2352x1568px — 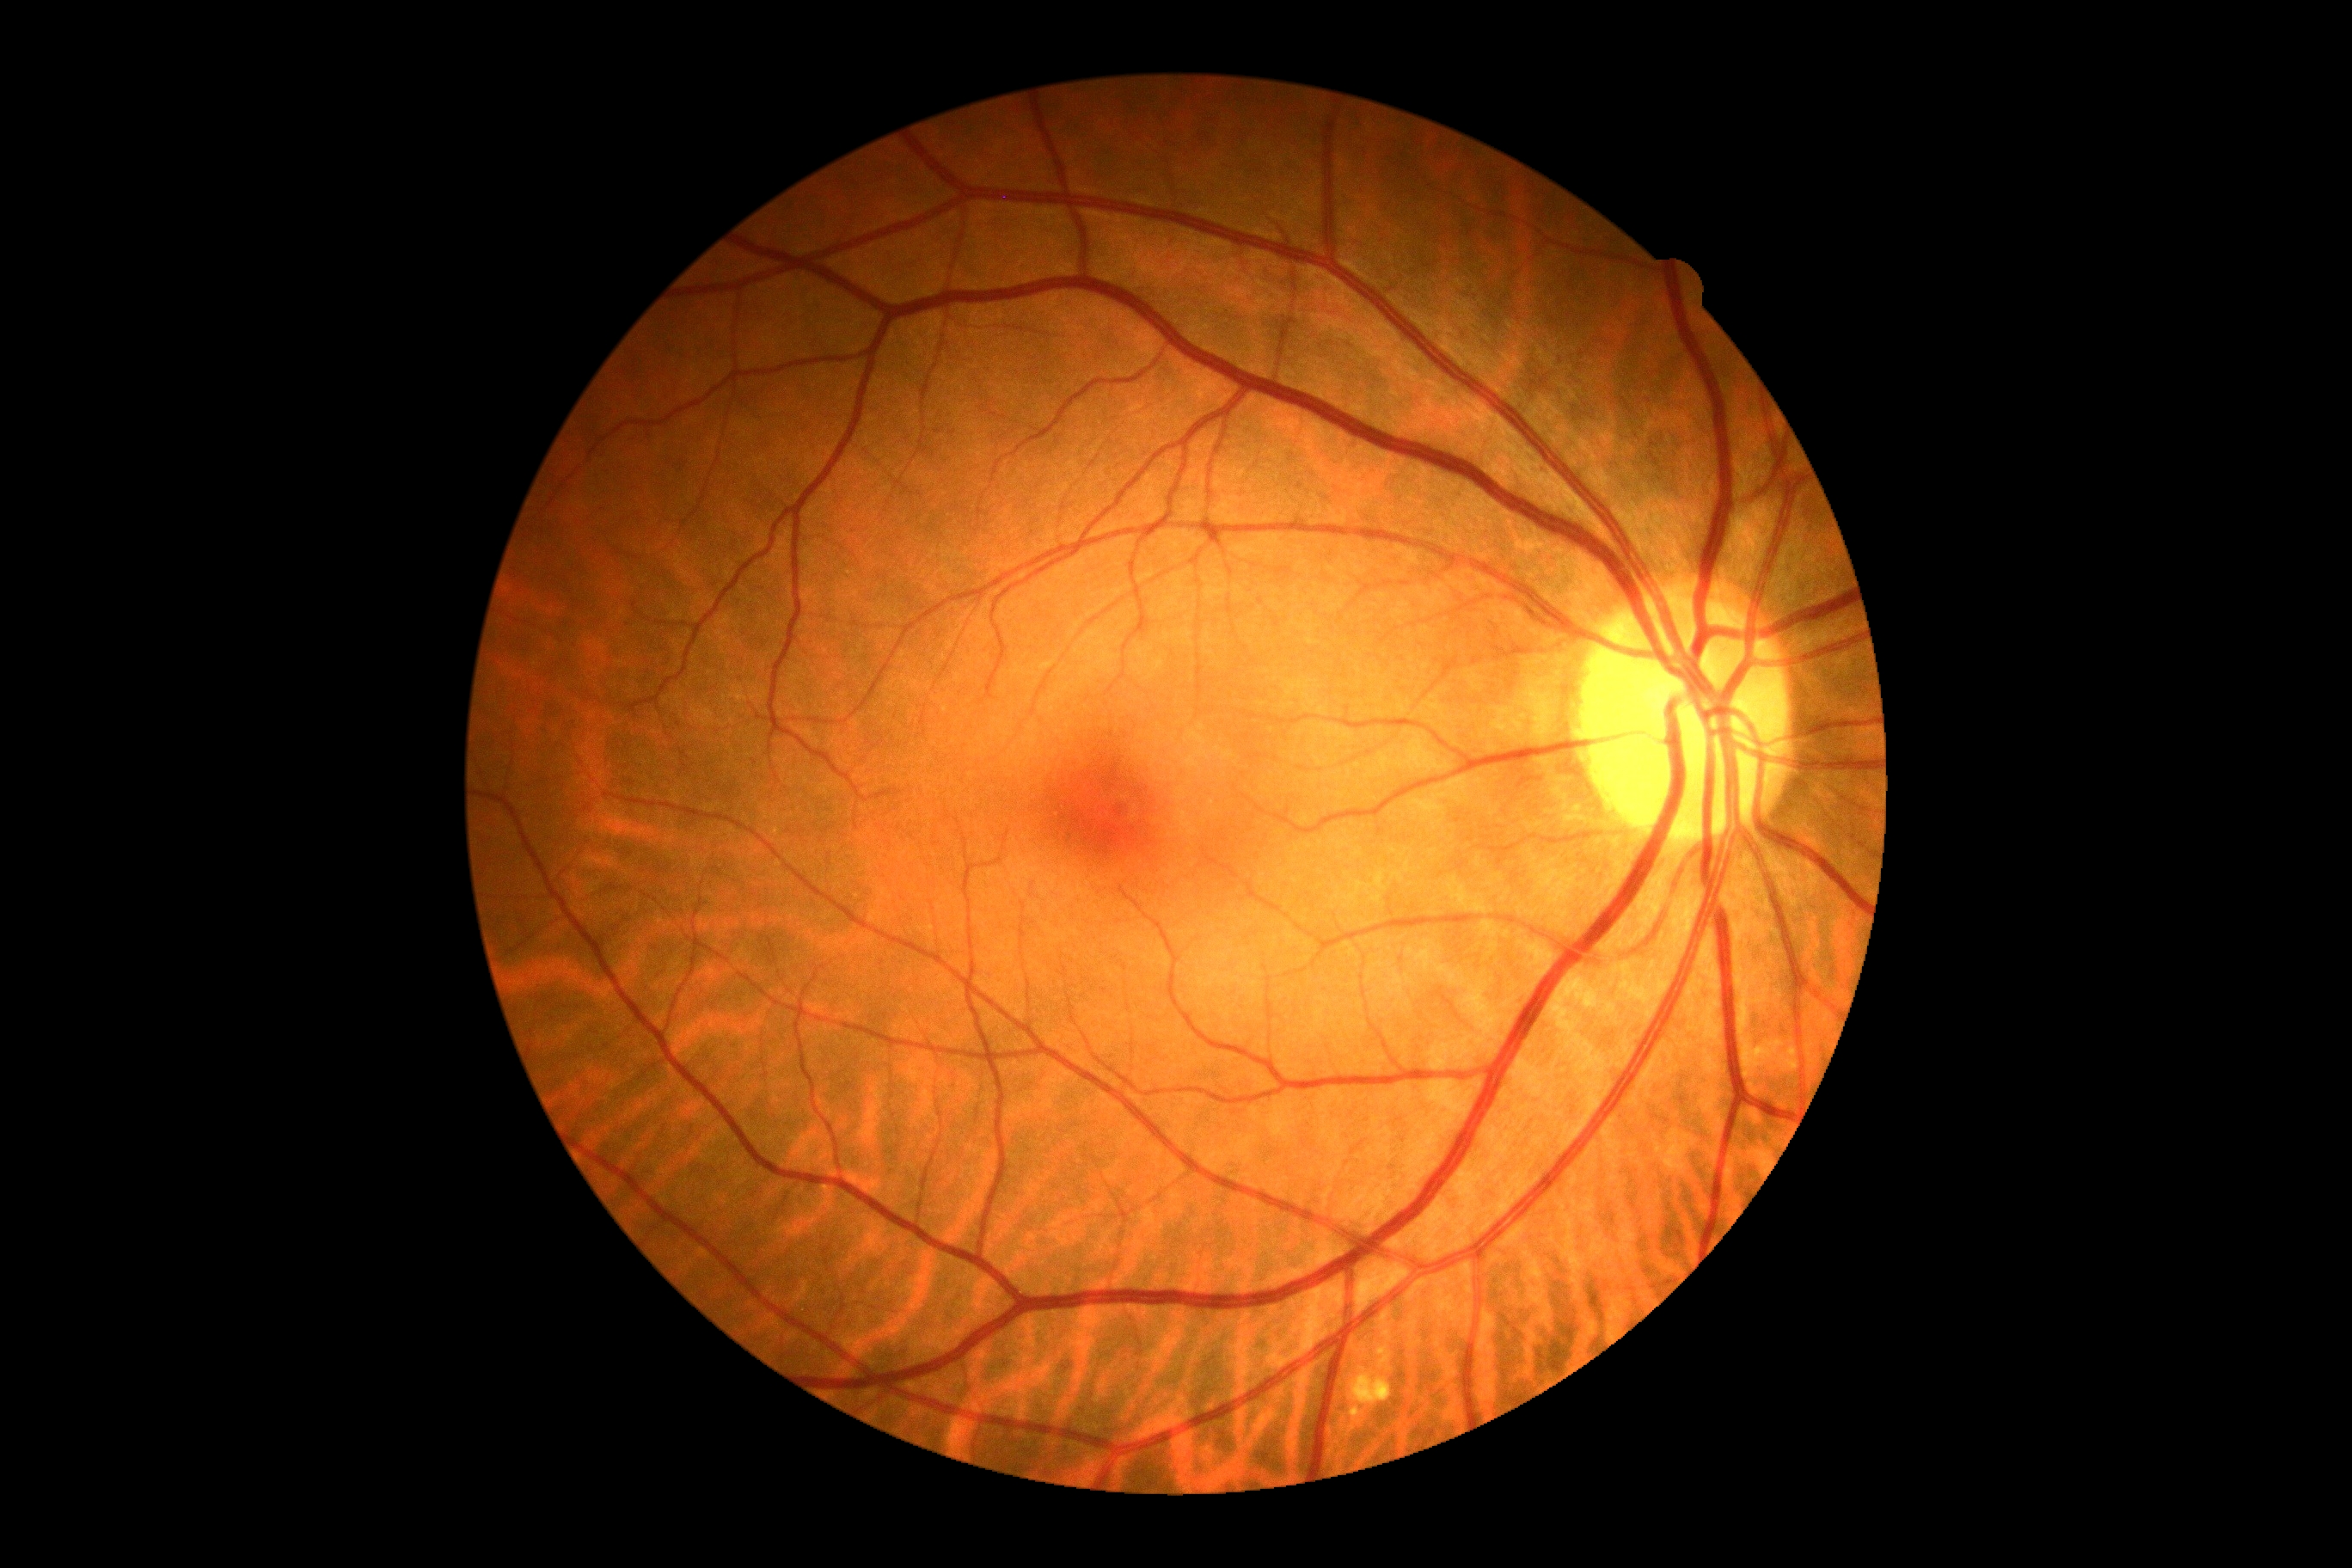
DR = grade 0 (no apparent retinopathy).